45-degree field of view
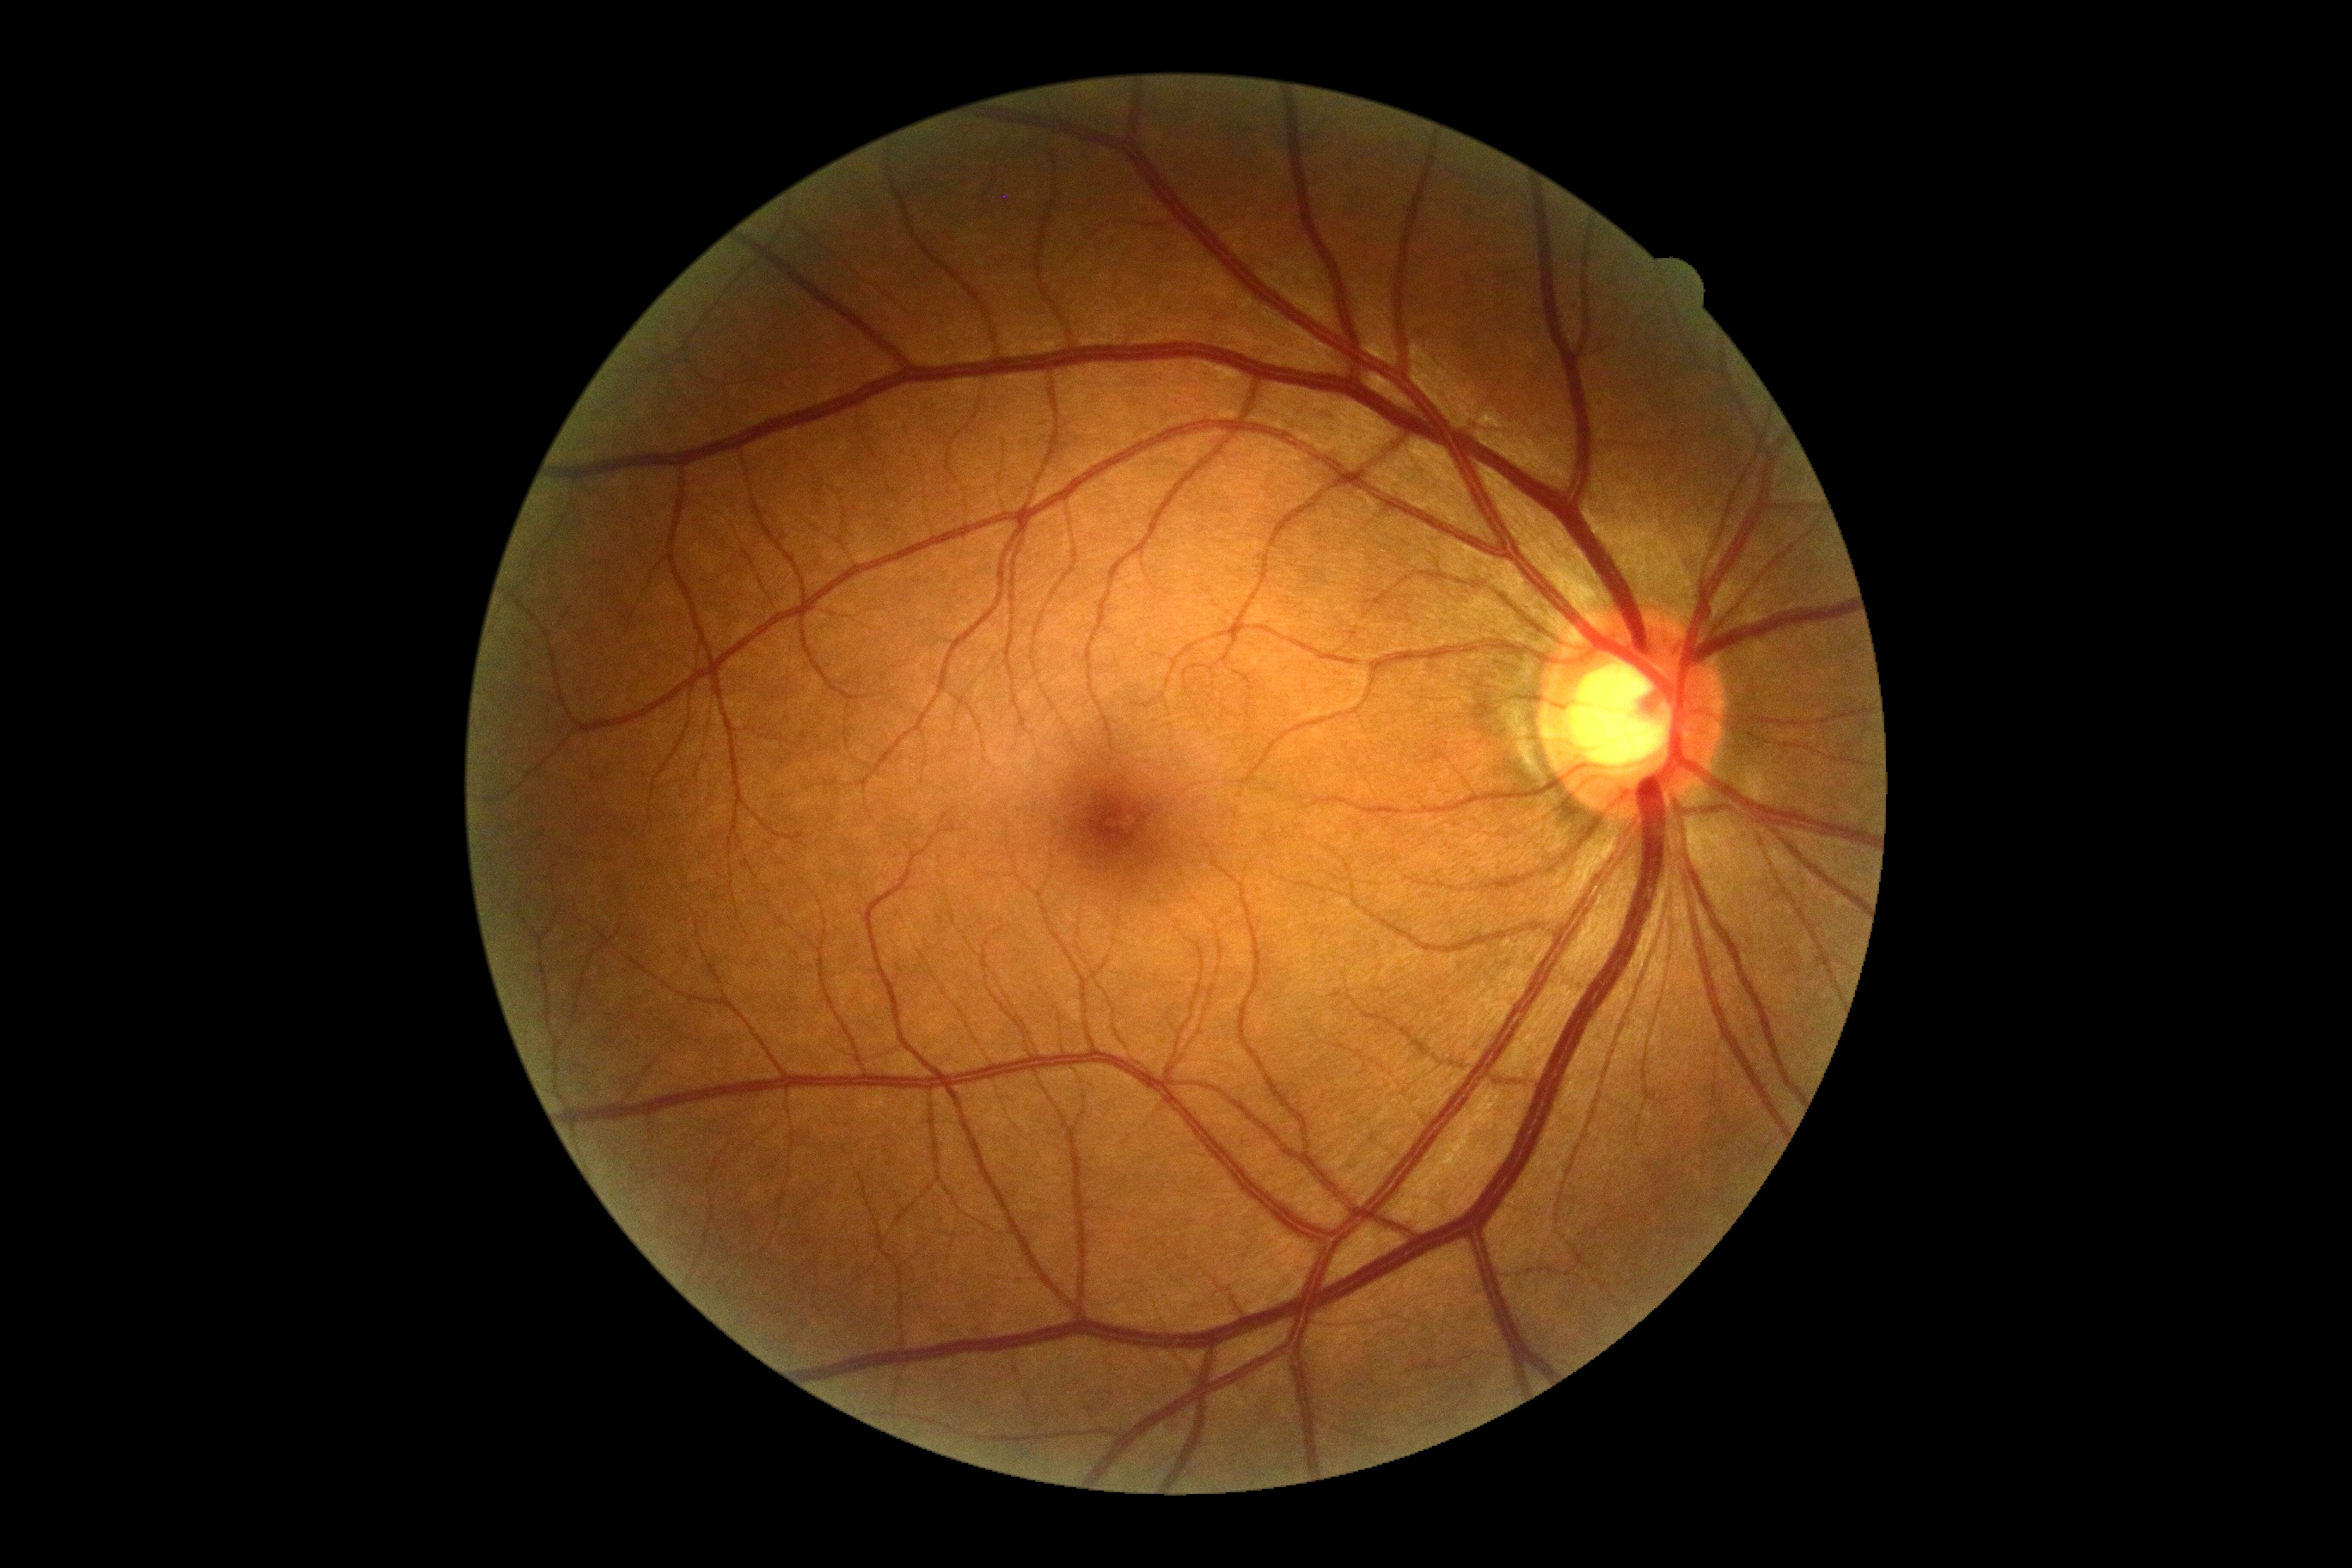

  dr_impression: no signs of DR
  dr_grade: 0/4 — no visible signs of diabetic retinopathy